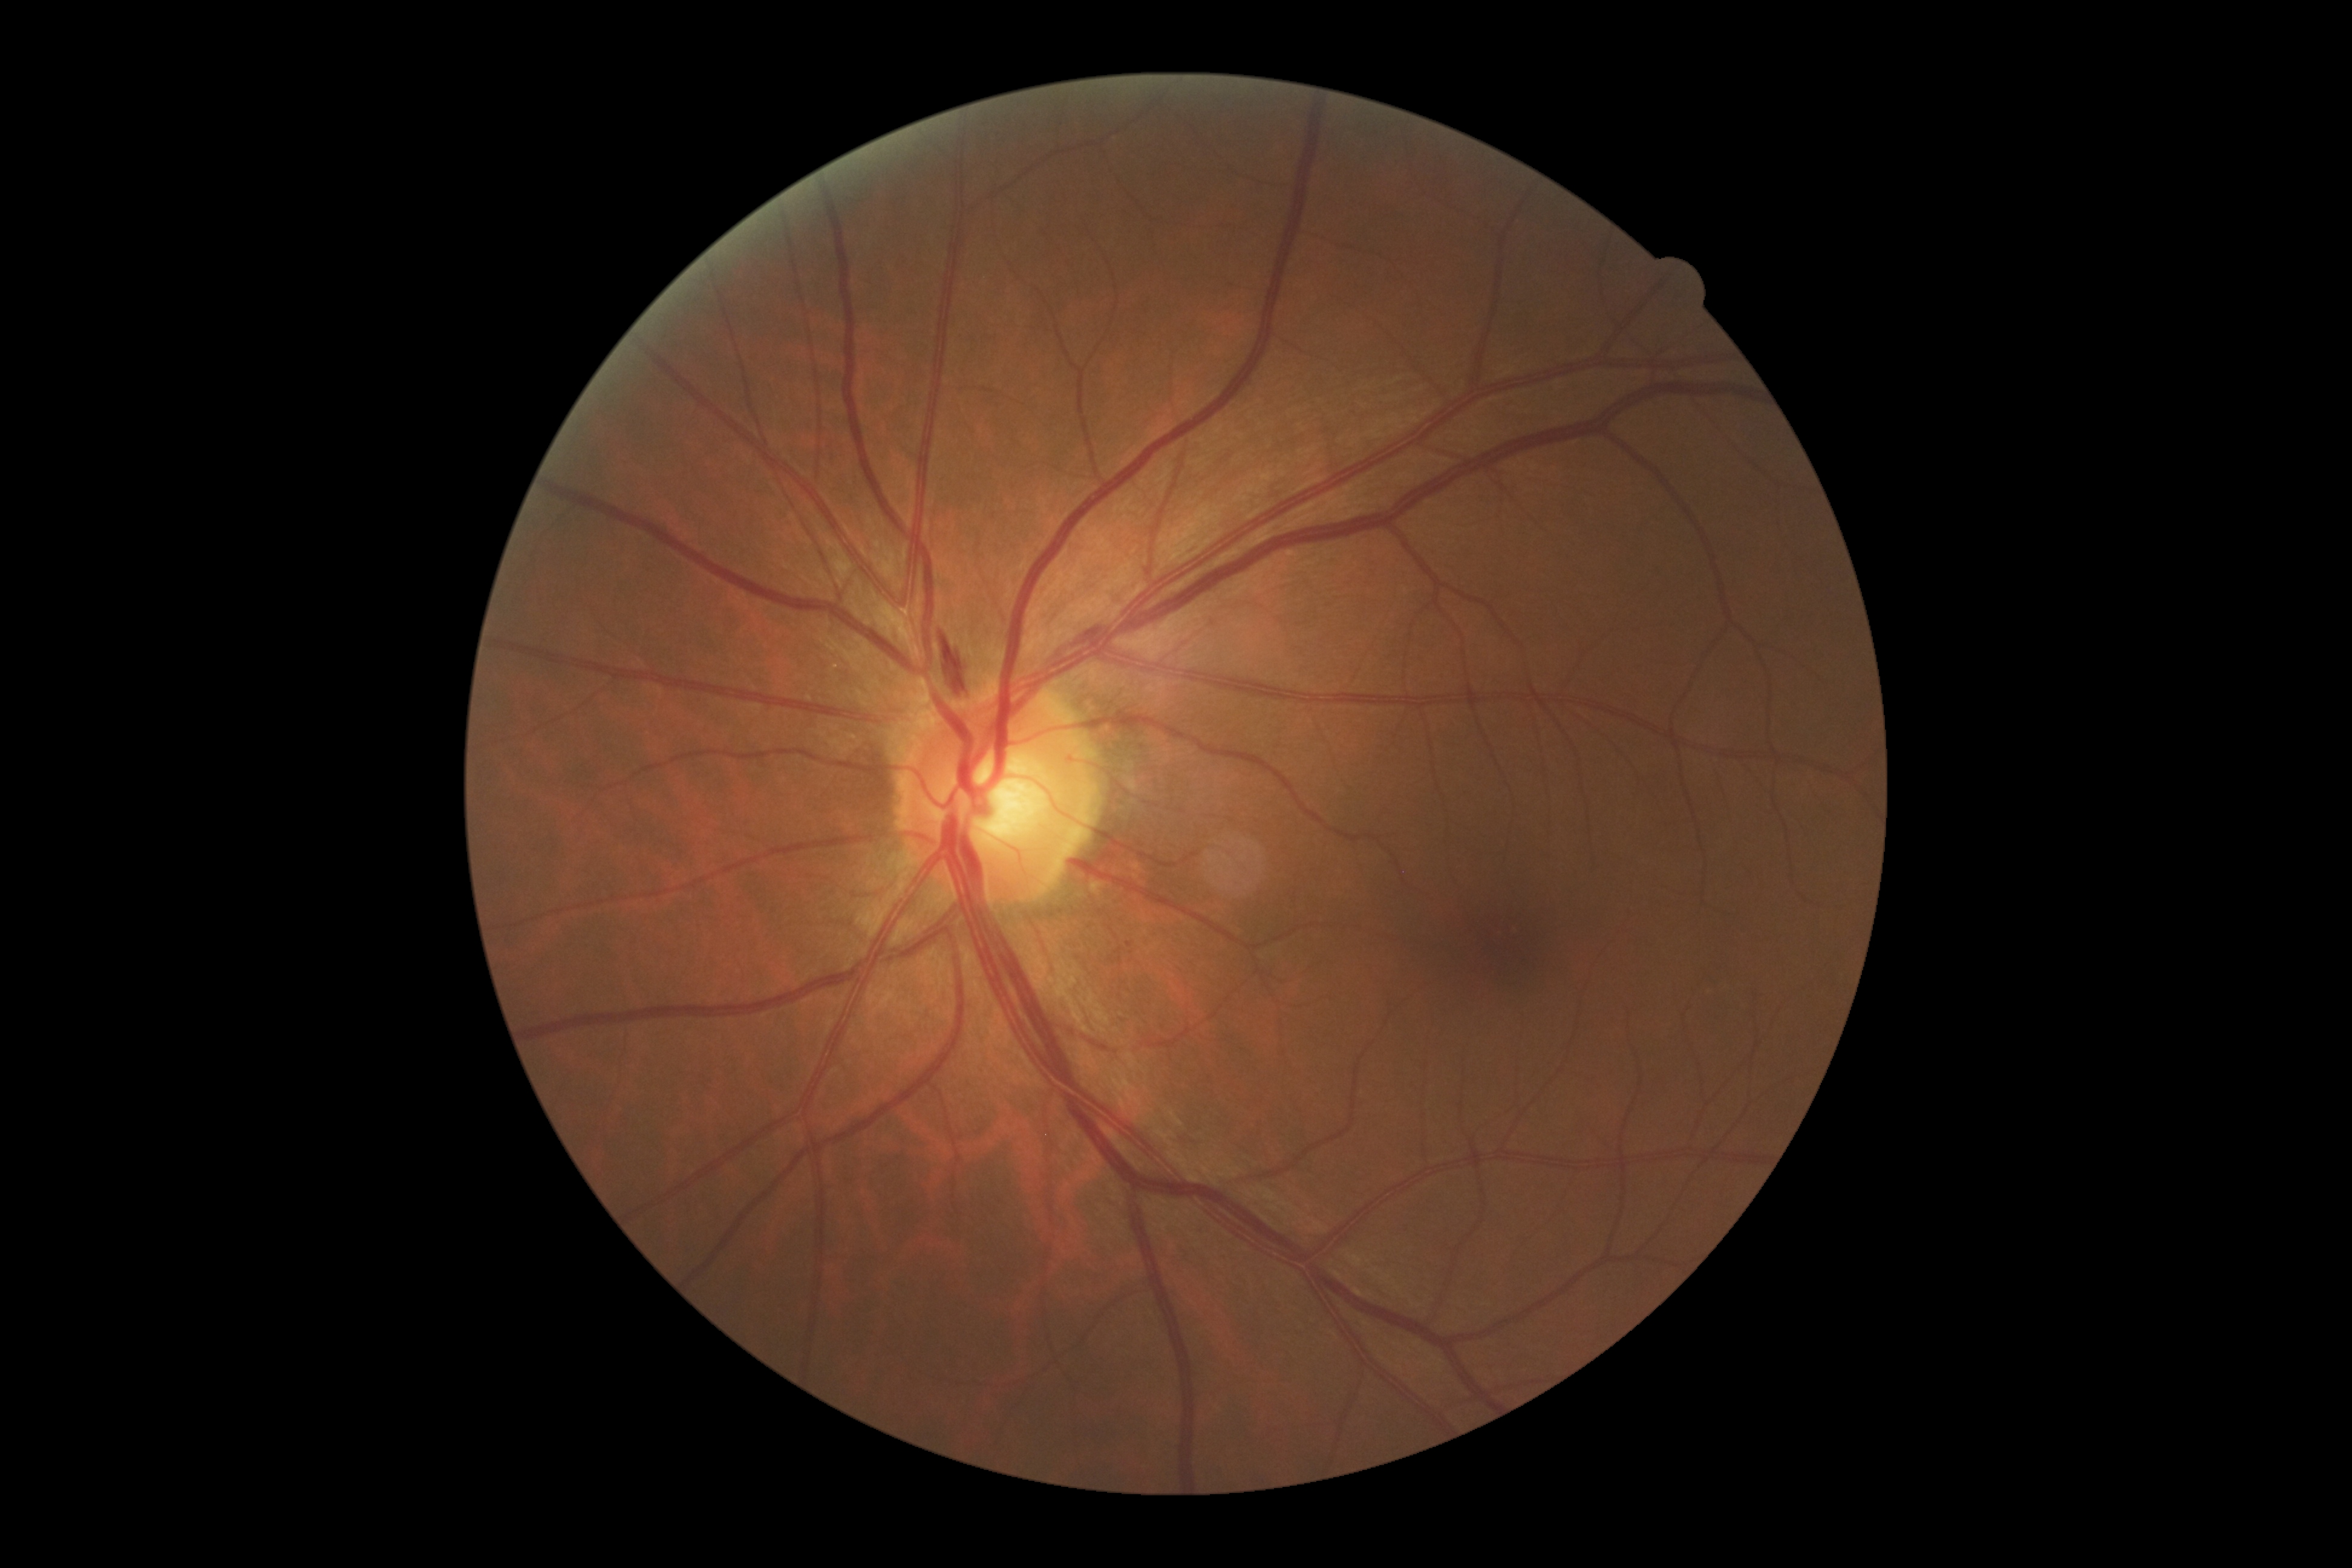 Diabetic retinopathy is 2/4.